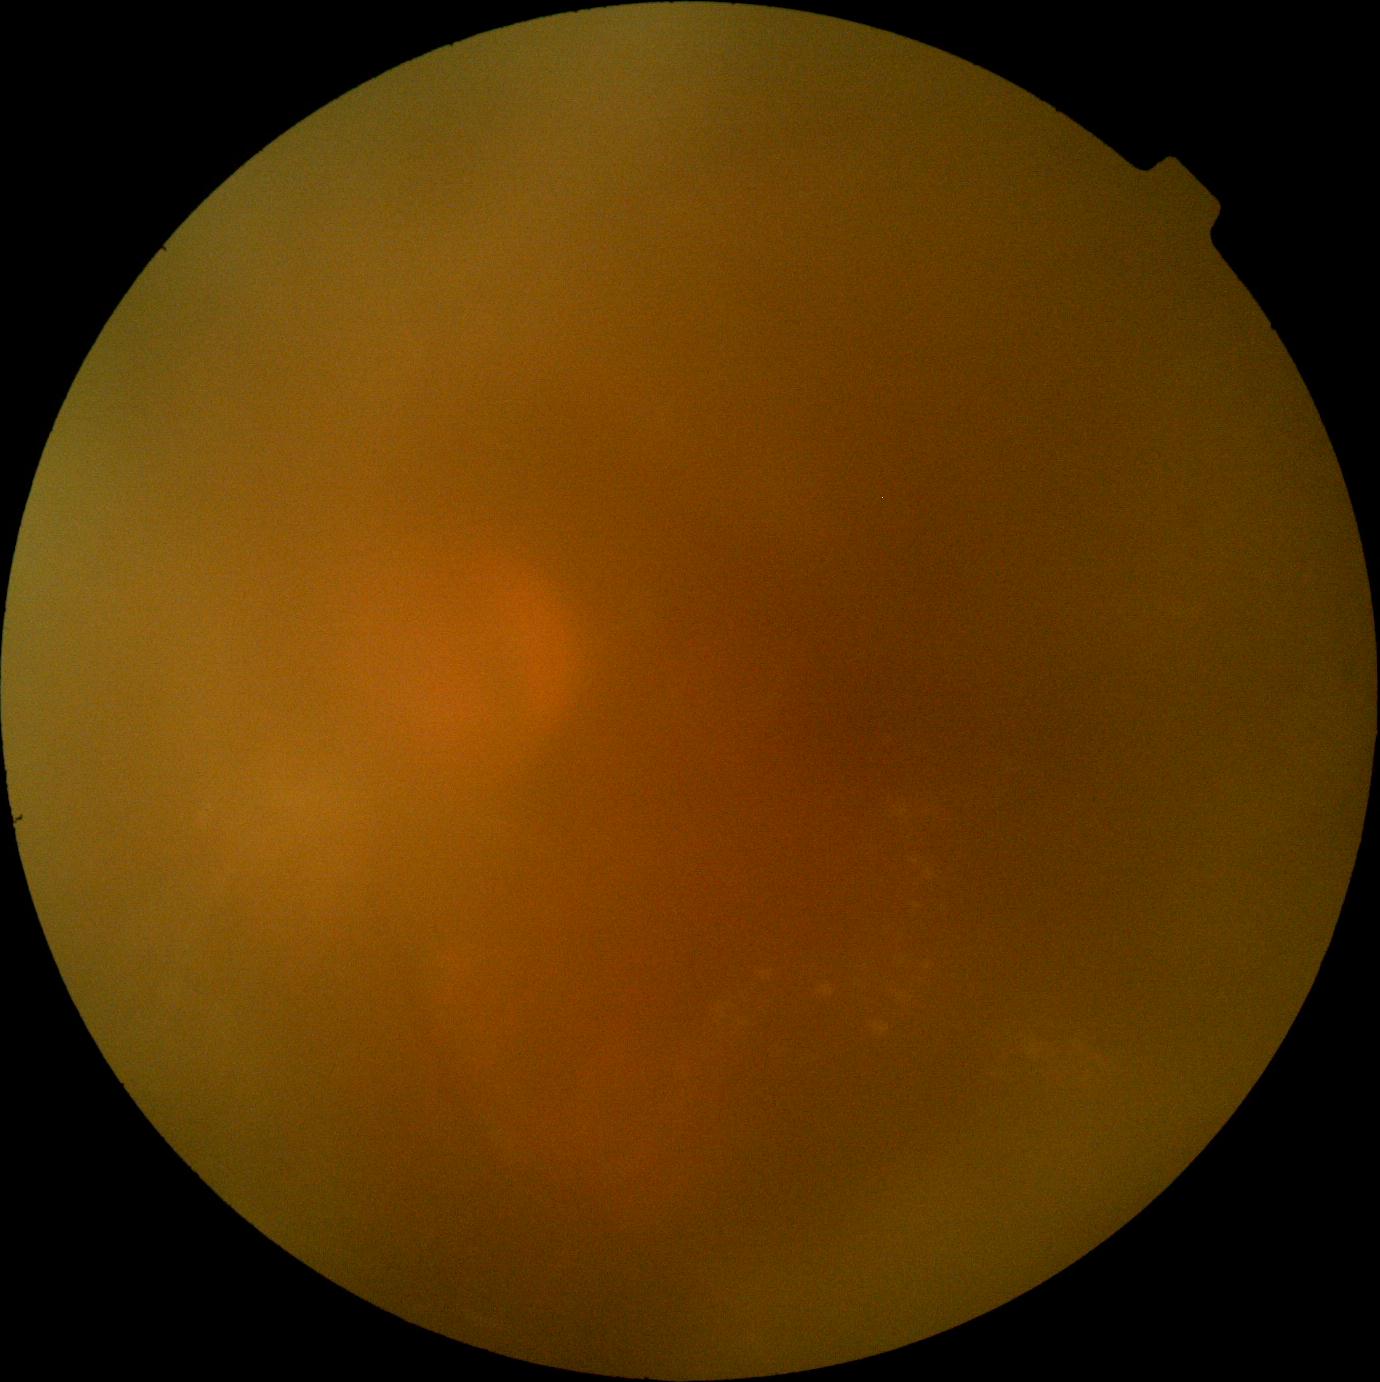

DR grade: 2 (moderate NPDR).